Color fundus photograph:
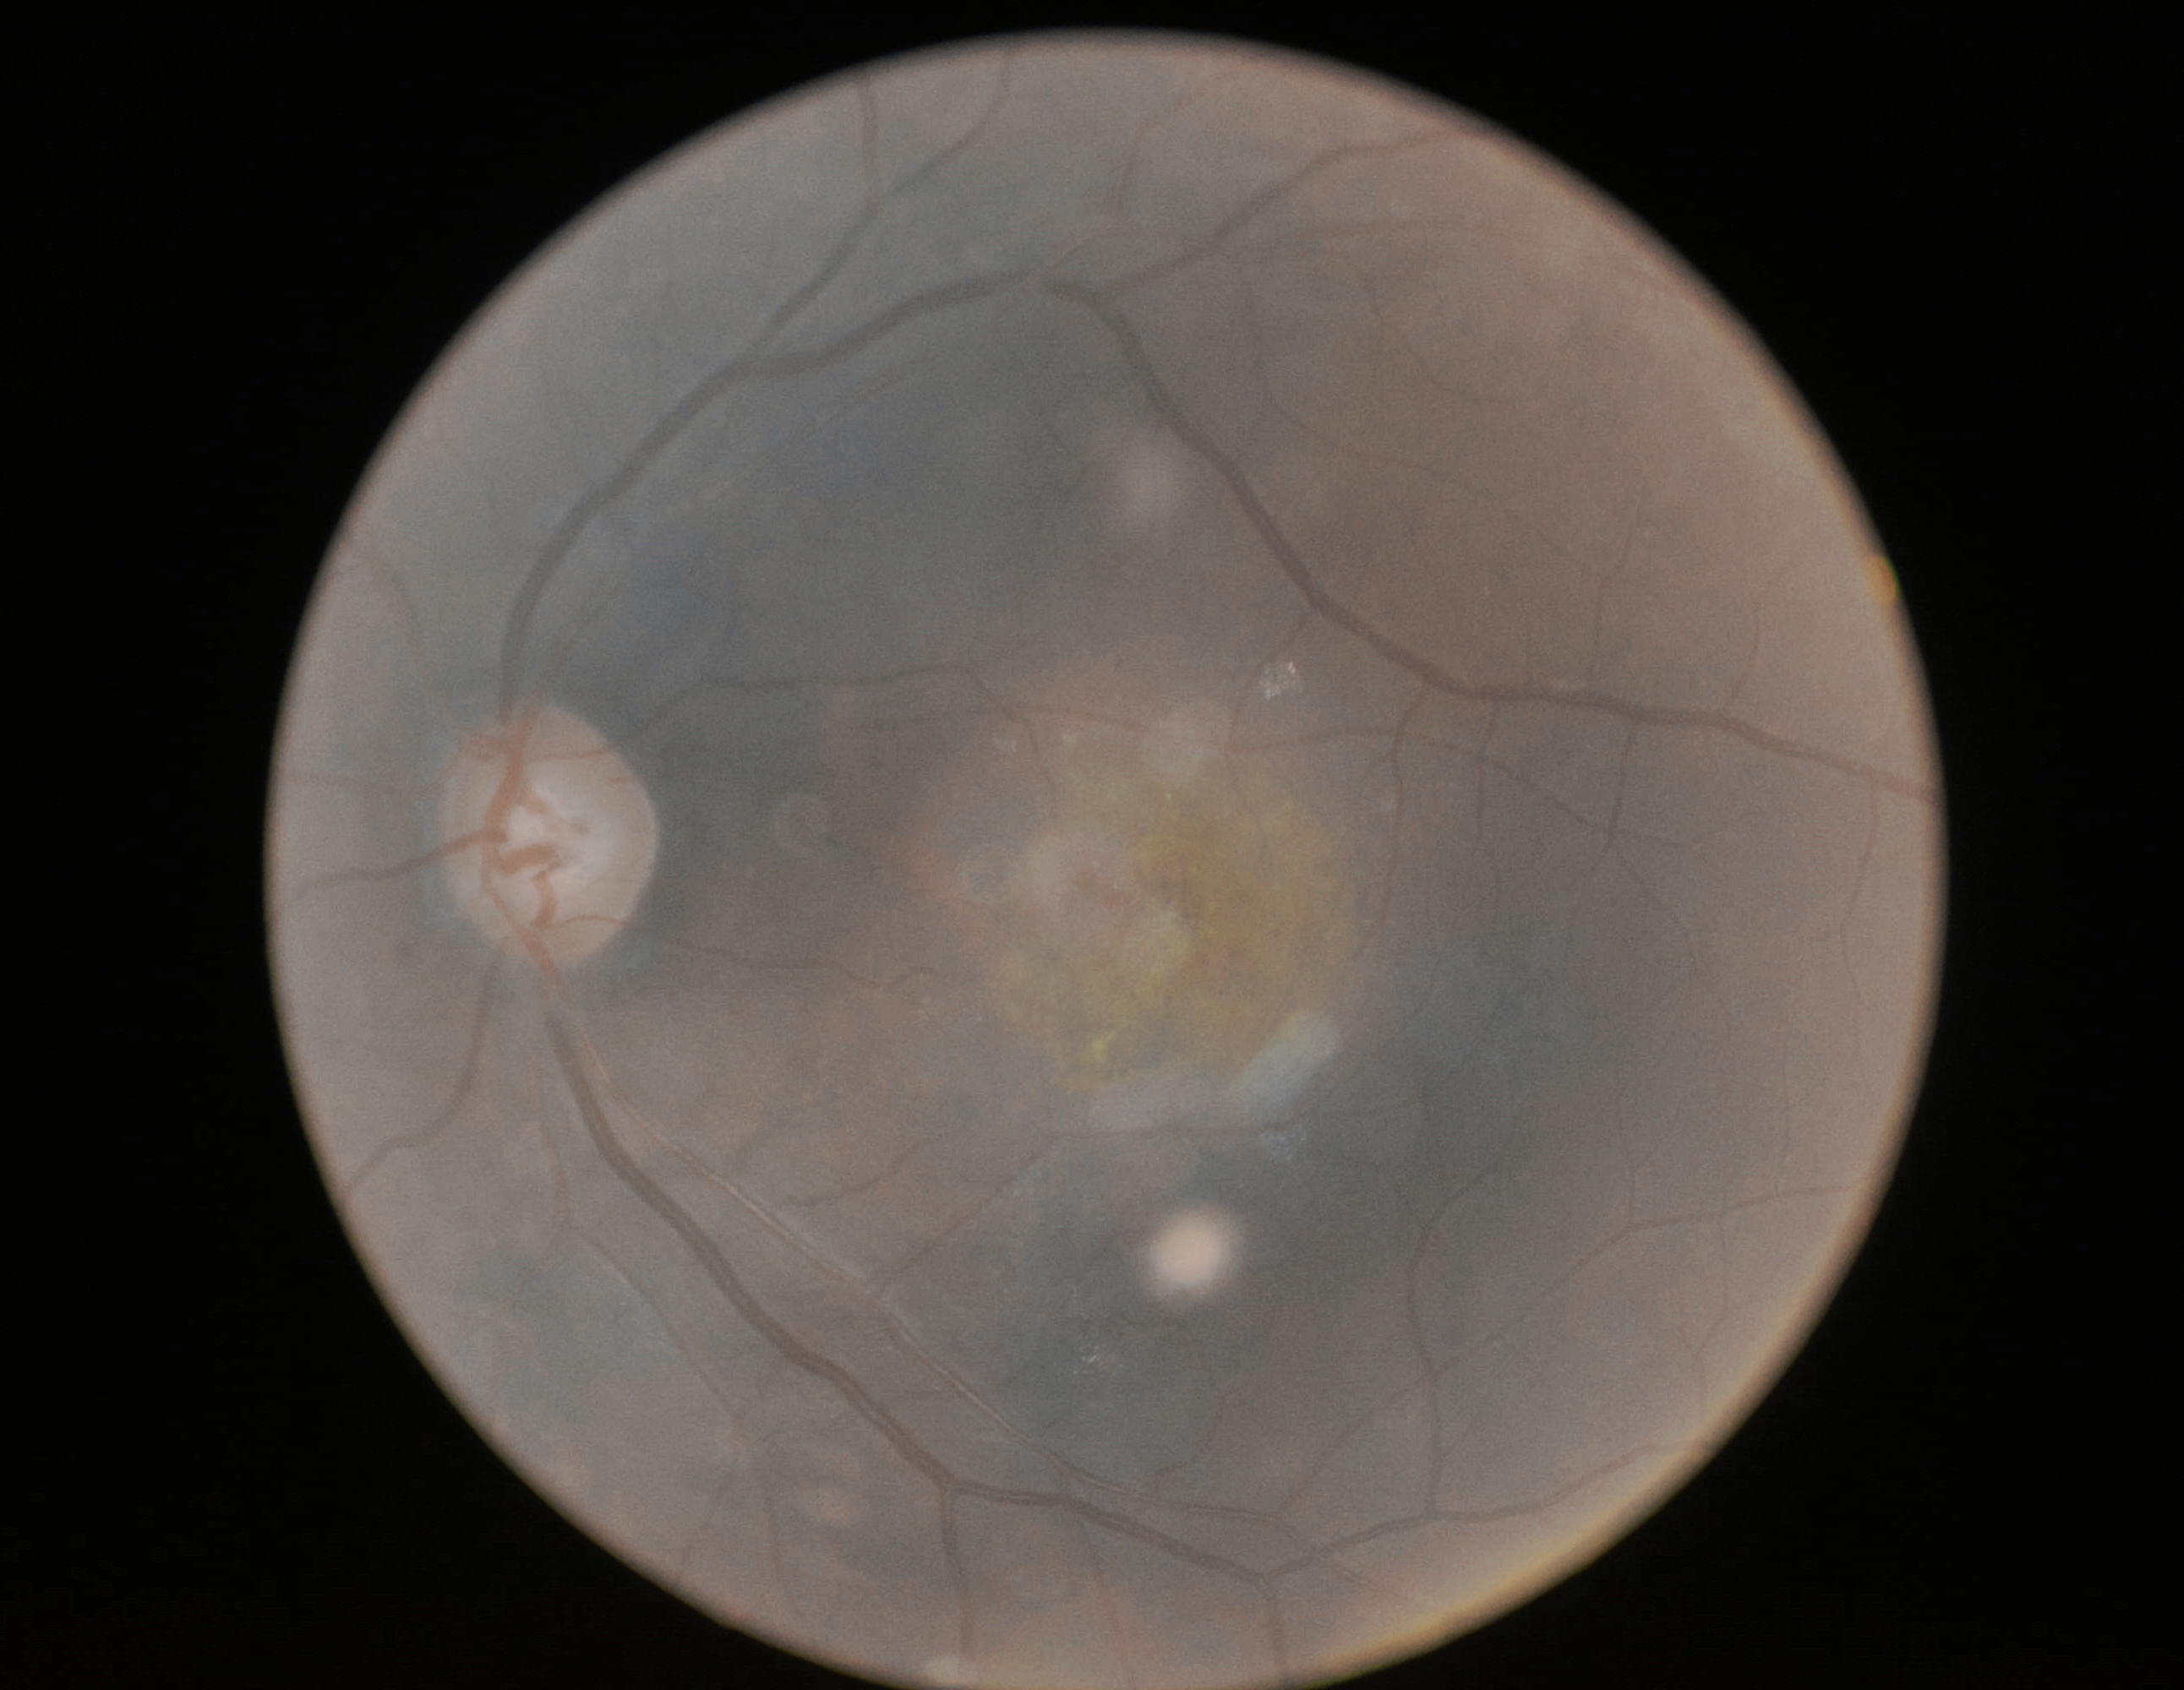
dr_grade: 2 — more than just microaneurysms but less than severe NPDR